50° FOV · captured after pupil dilation · acquired with a Topcon TRC-50DX:
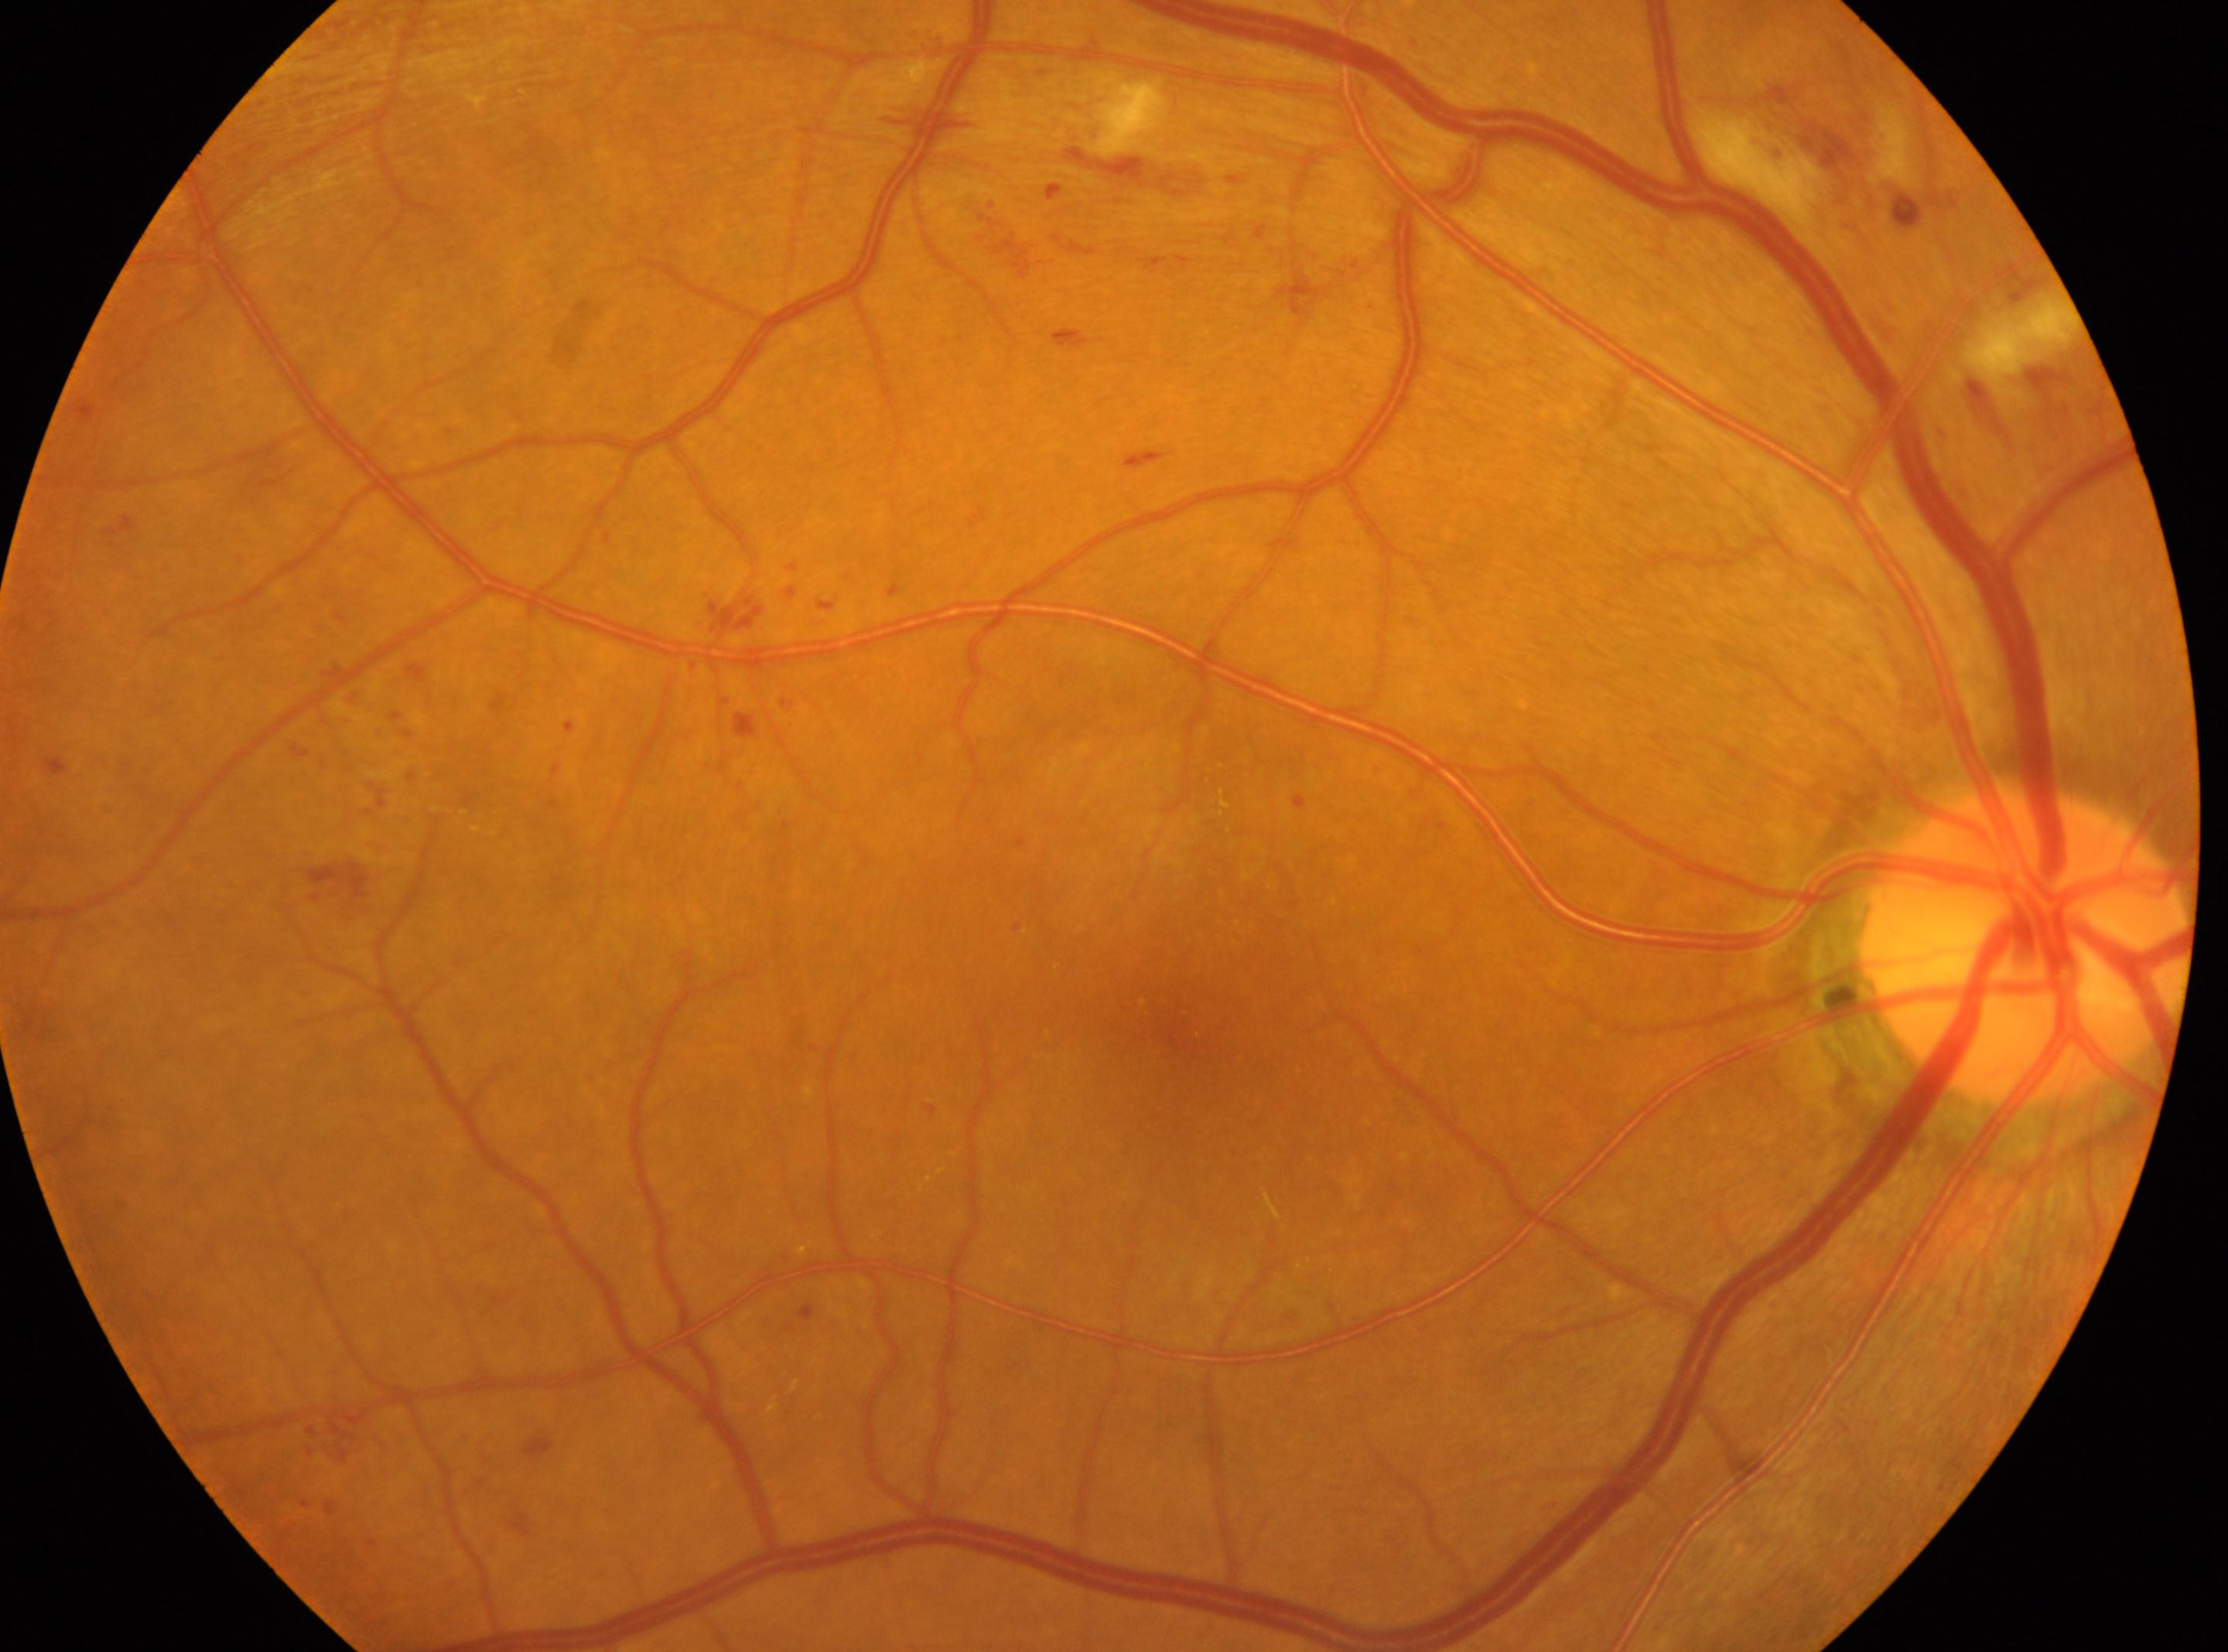

Retinopathy grade is 2 (moderate NPDR). The optic disc center is at (x=2024, y=947). The image shows the right eye. Foveal center located at (x=1179, y=1035).